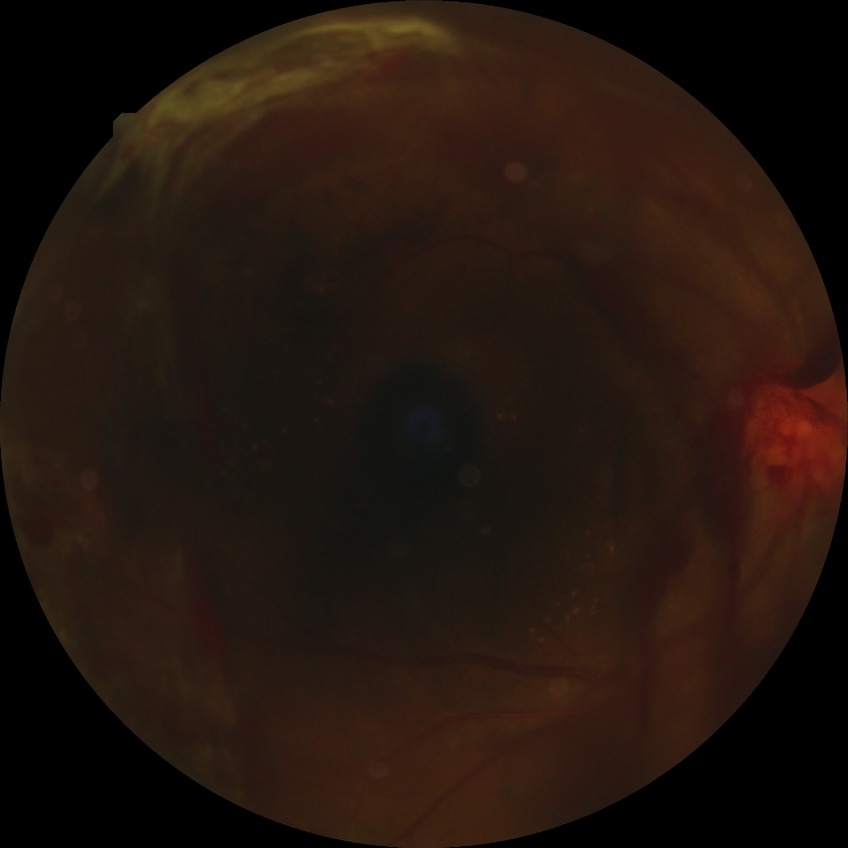
Davis stage is PDR.